FOV: 50 degrees:
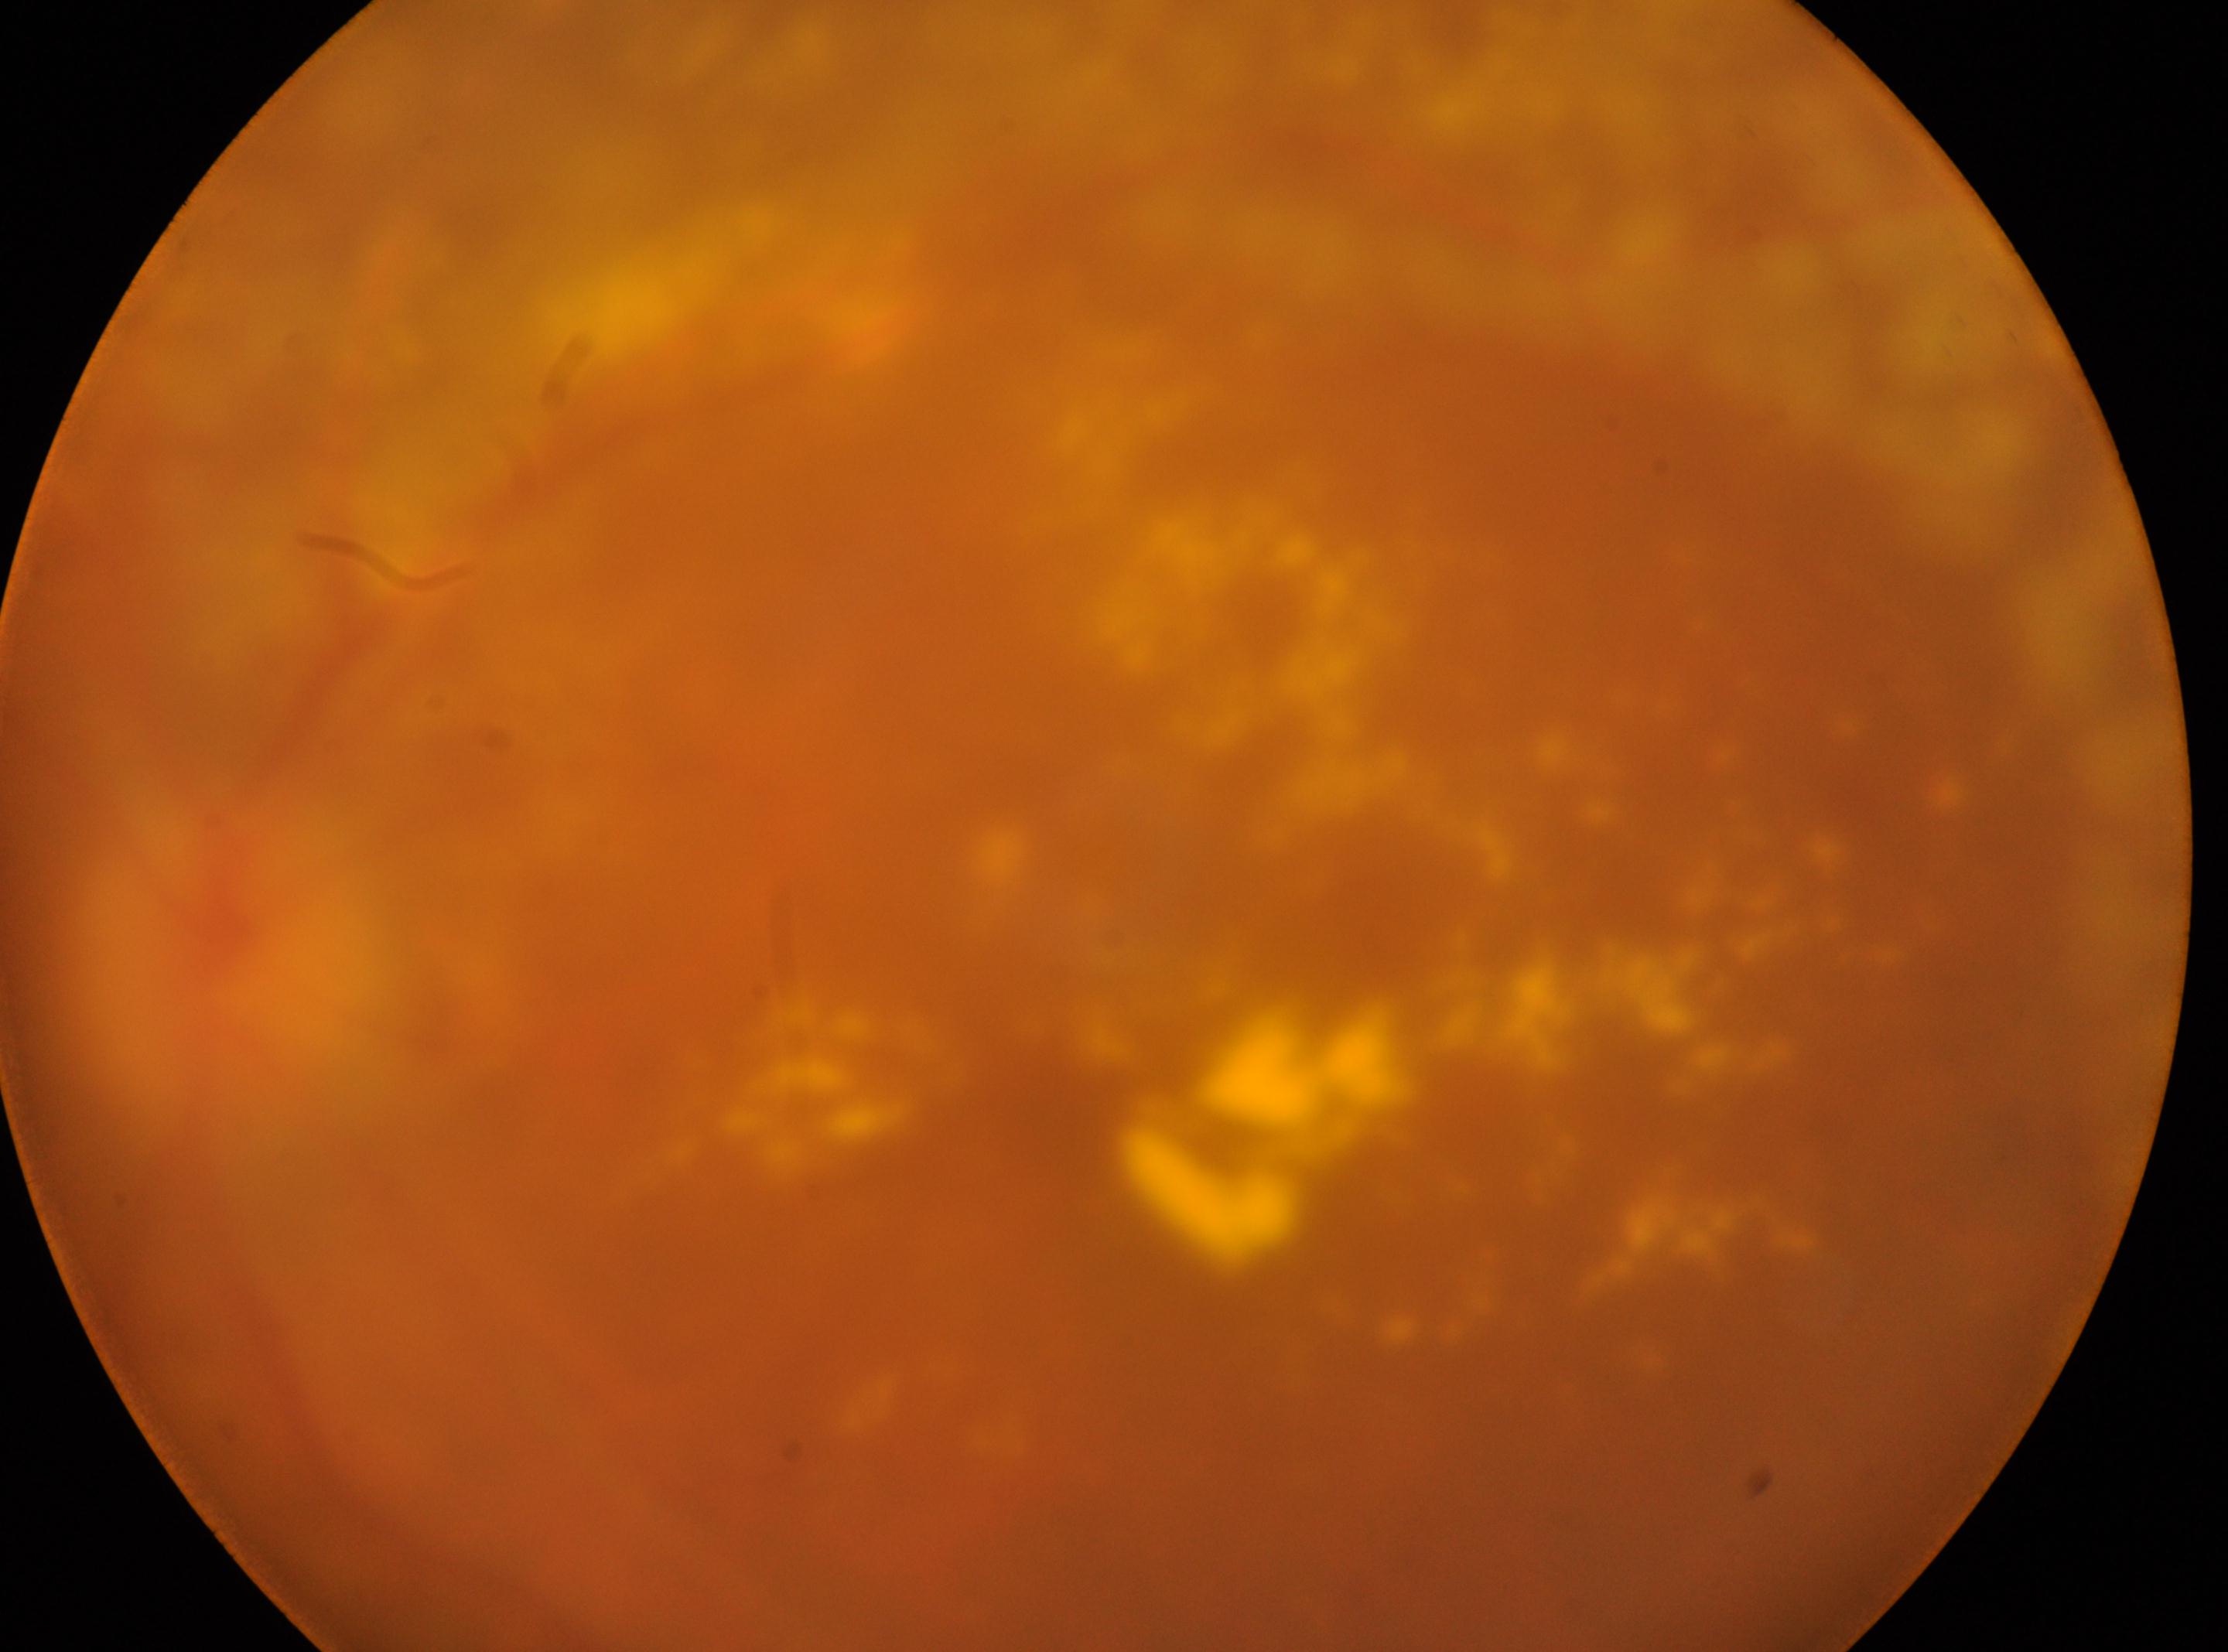 Imaged eye: left.
Diabetic retinopathy (DR): DR with laser photocoagulation scars.
The disc center is at (221,958).
Macular center: (1035,1100).